Nonmydriatic; diabetic retinopathy graded by the modified Davis classification; NIDEK AFC-230 fundus camera:
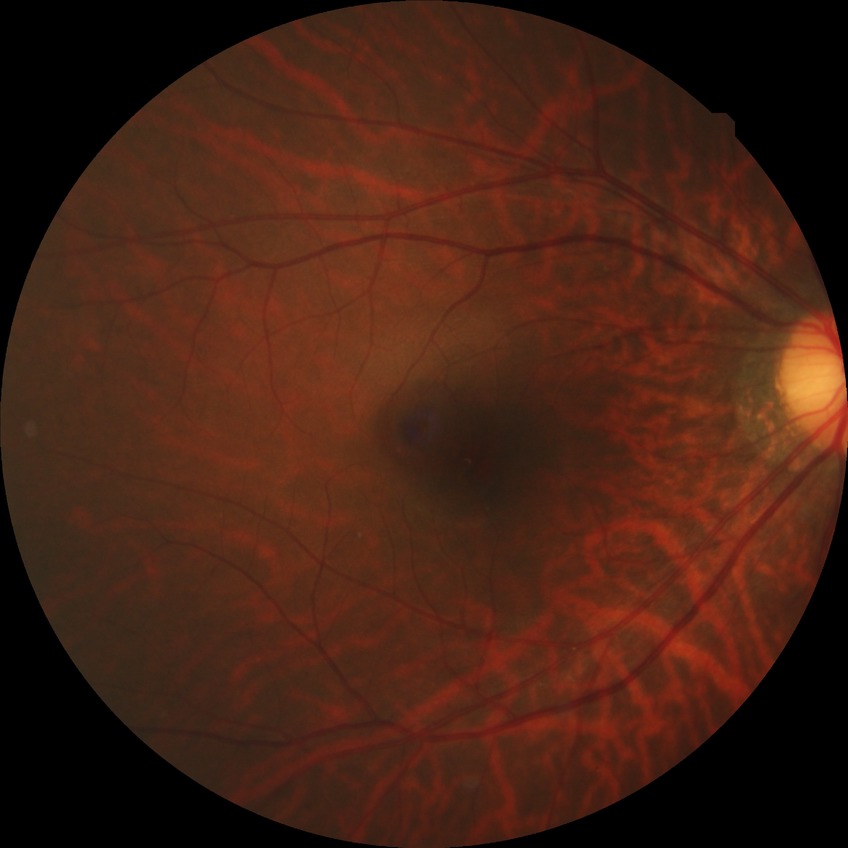 Assessment:
* diabetic retinopathy stage — no diabetic retinopathy